2352 x 1568 pixels: 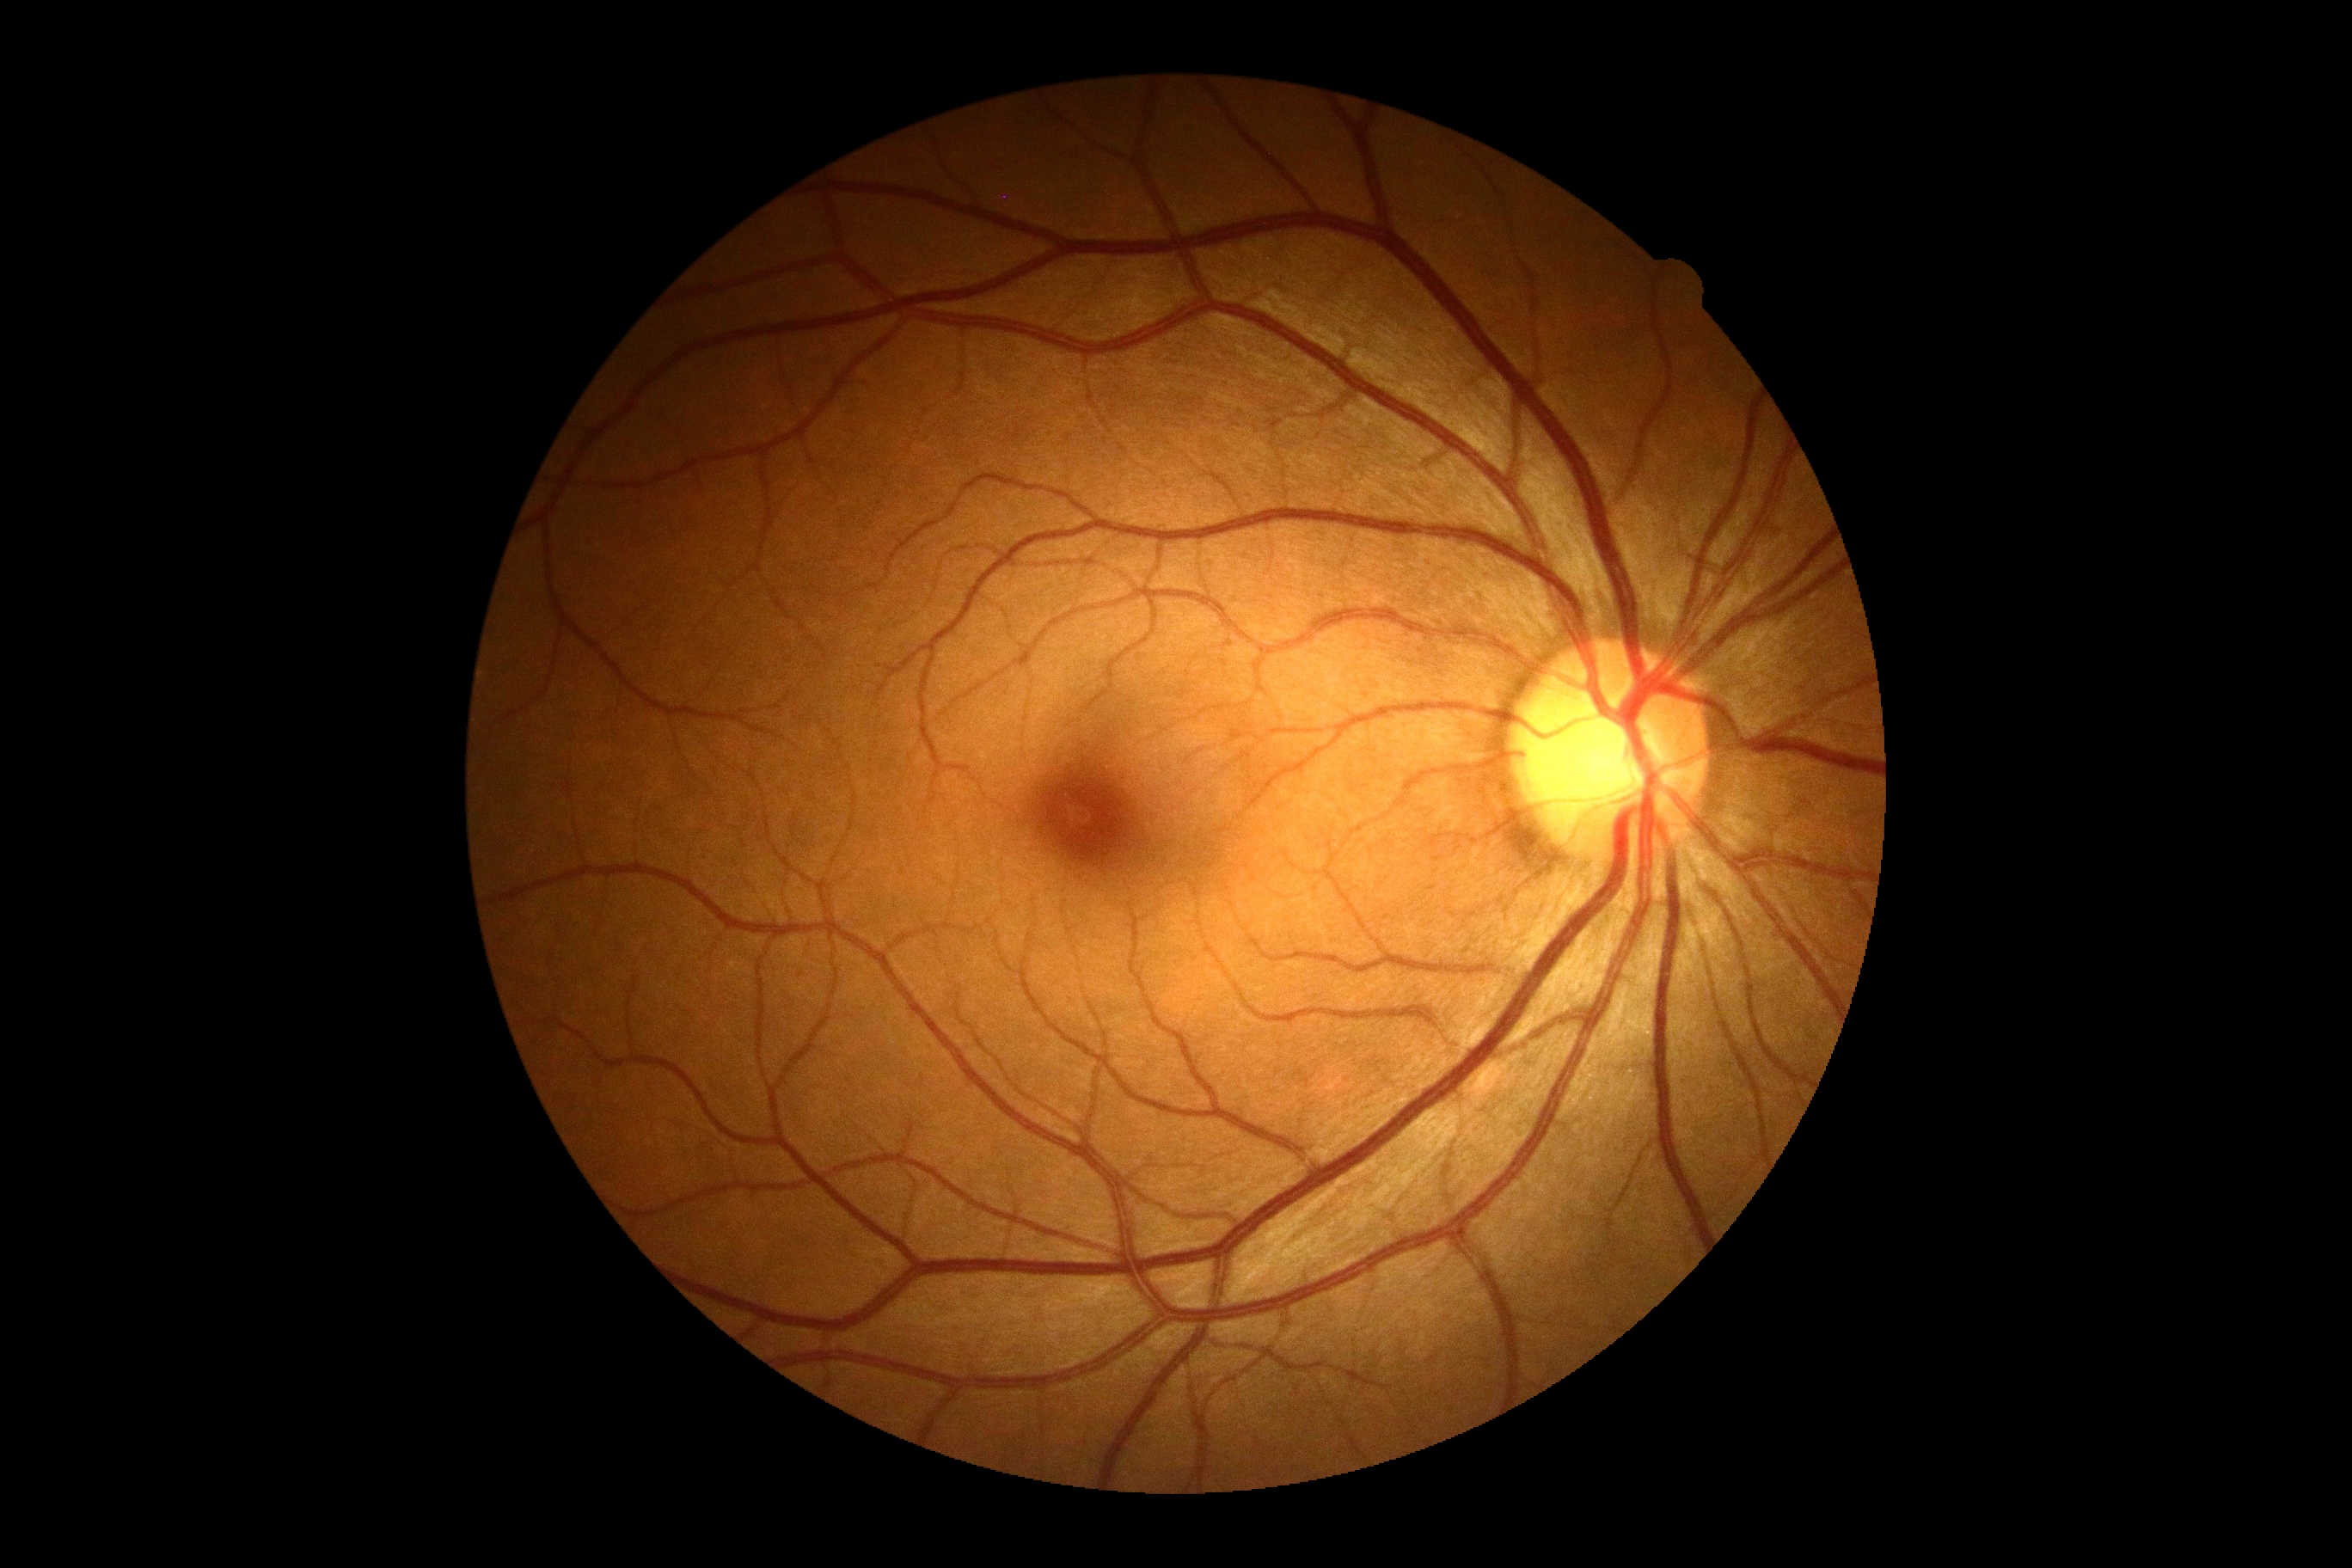

DR grade: 0 — no visible signs of diabetic retinopathy.